Optic disc-centered; acquired with a Topcon TRC-NW400:
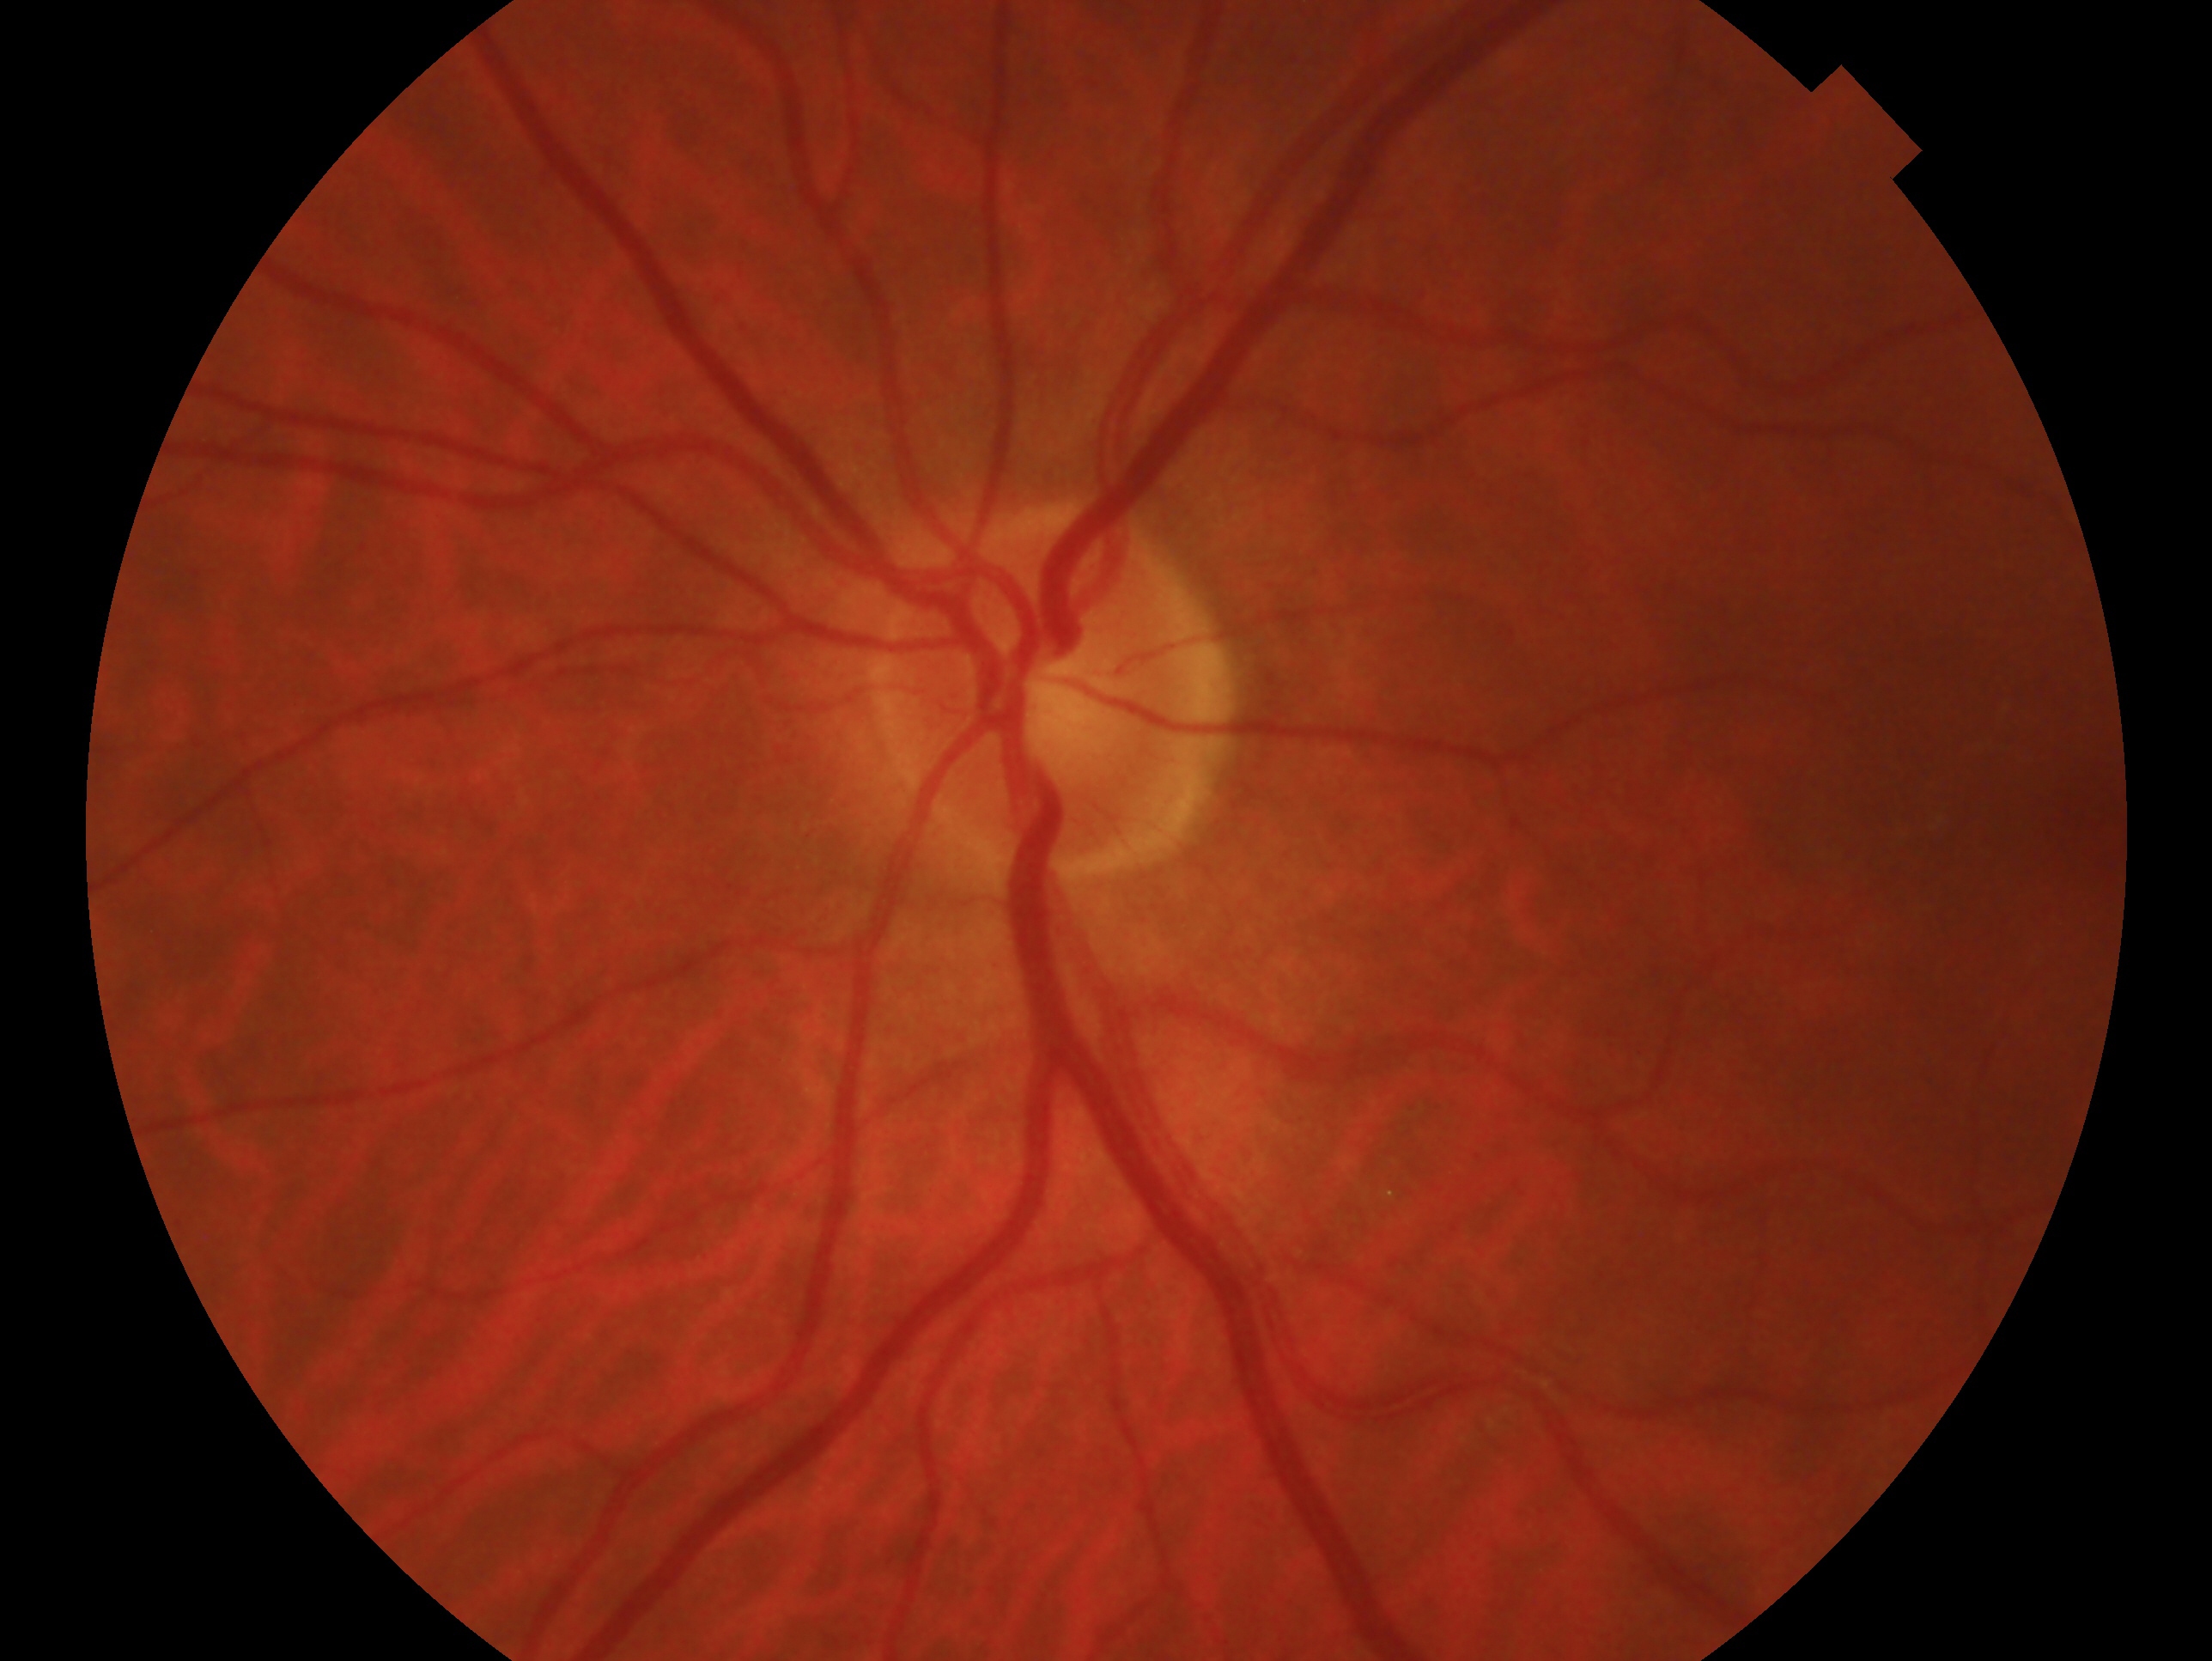 Imaged eye: left eye. Clinical classification — negative for glaucoma.